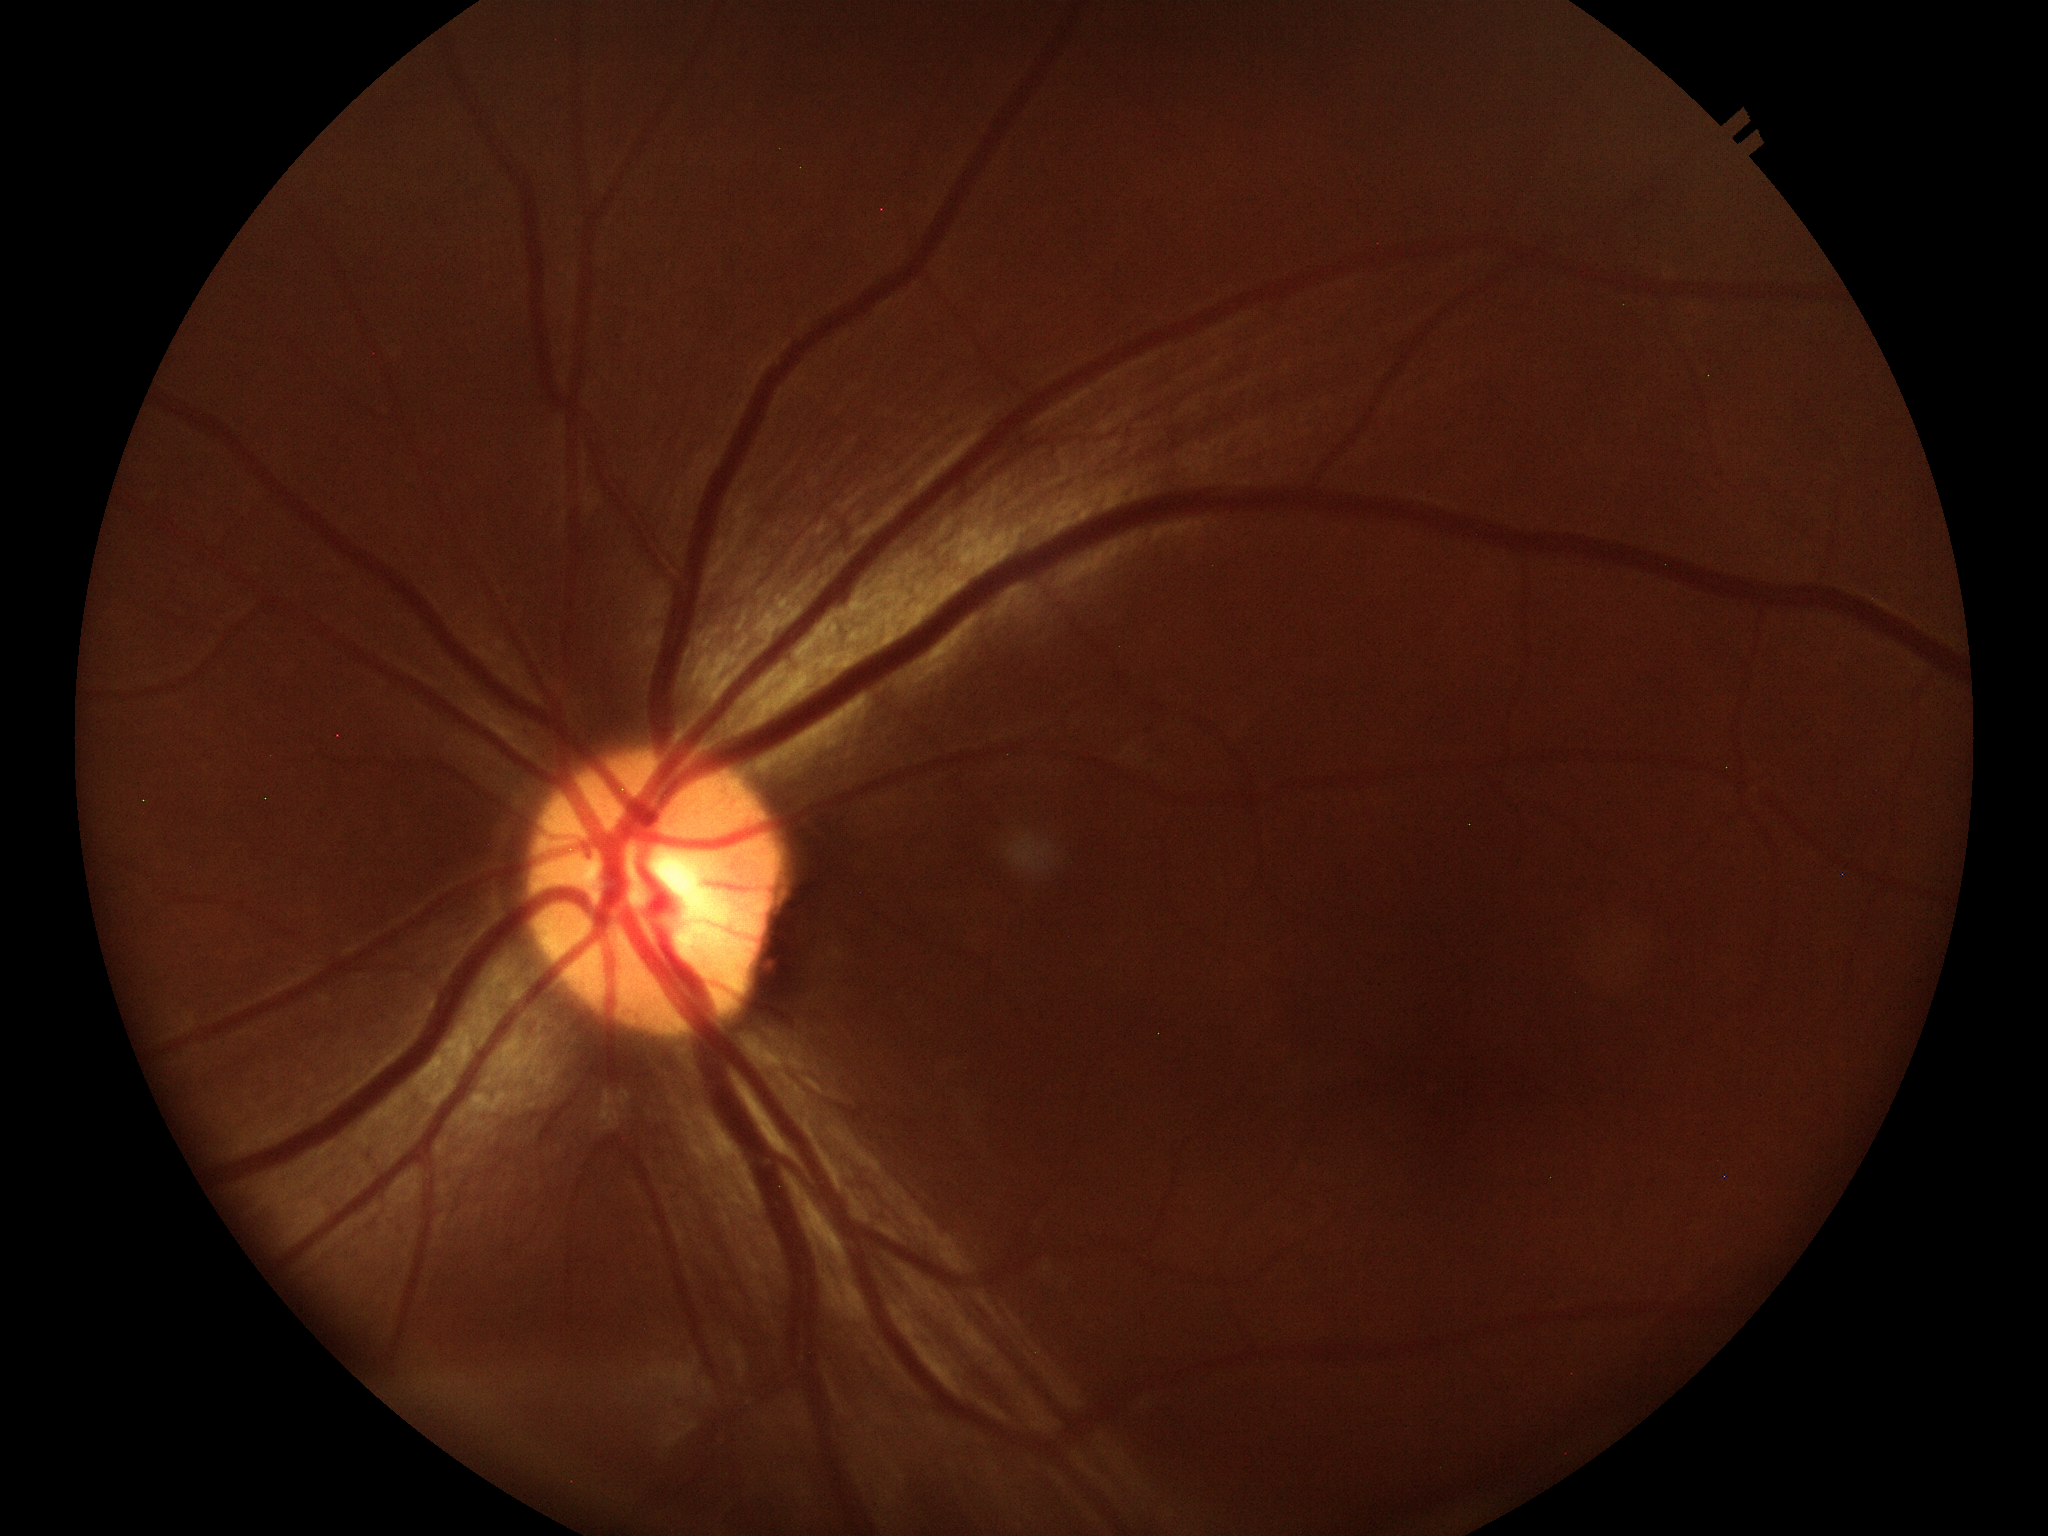
Area cup-to-disc ratio of 0.24.
Vertical CDR of 0.50.
No glaucomatous optic neuropathy (unanimous normal call).